Captured on a Bosch fundus camera; color fundus photograph: 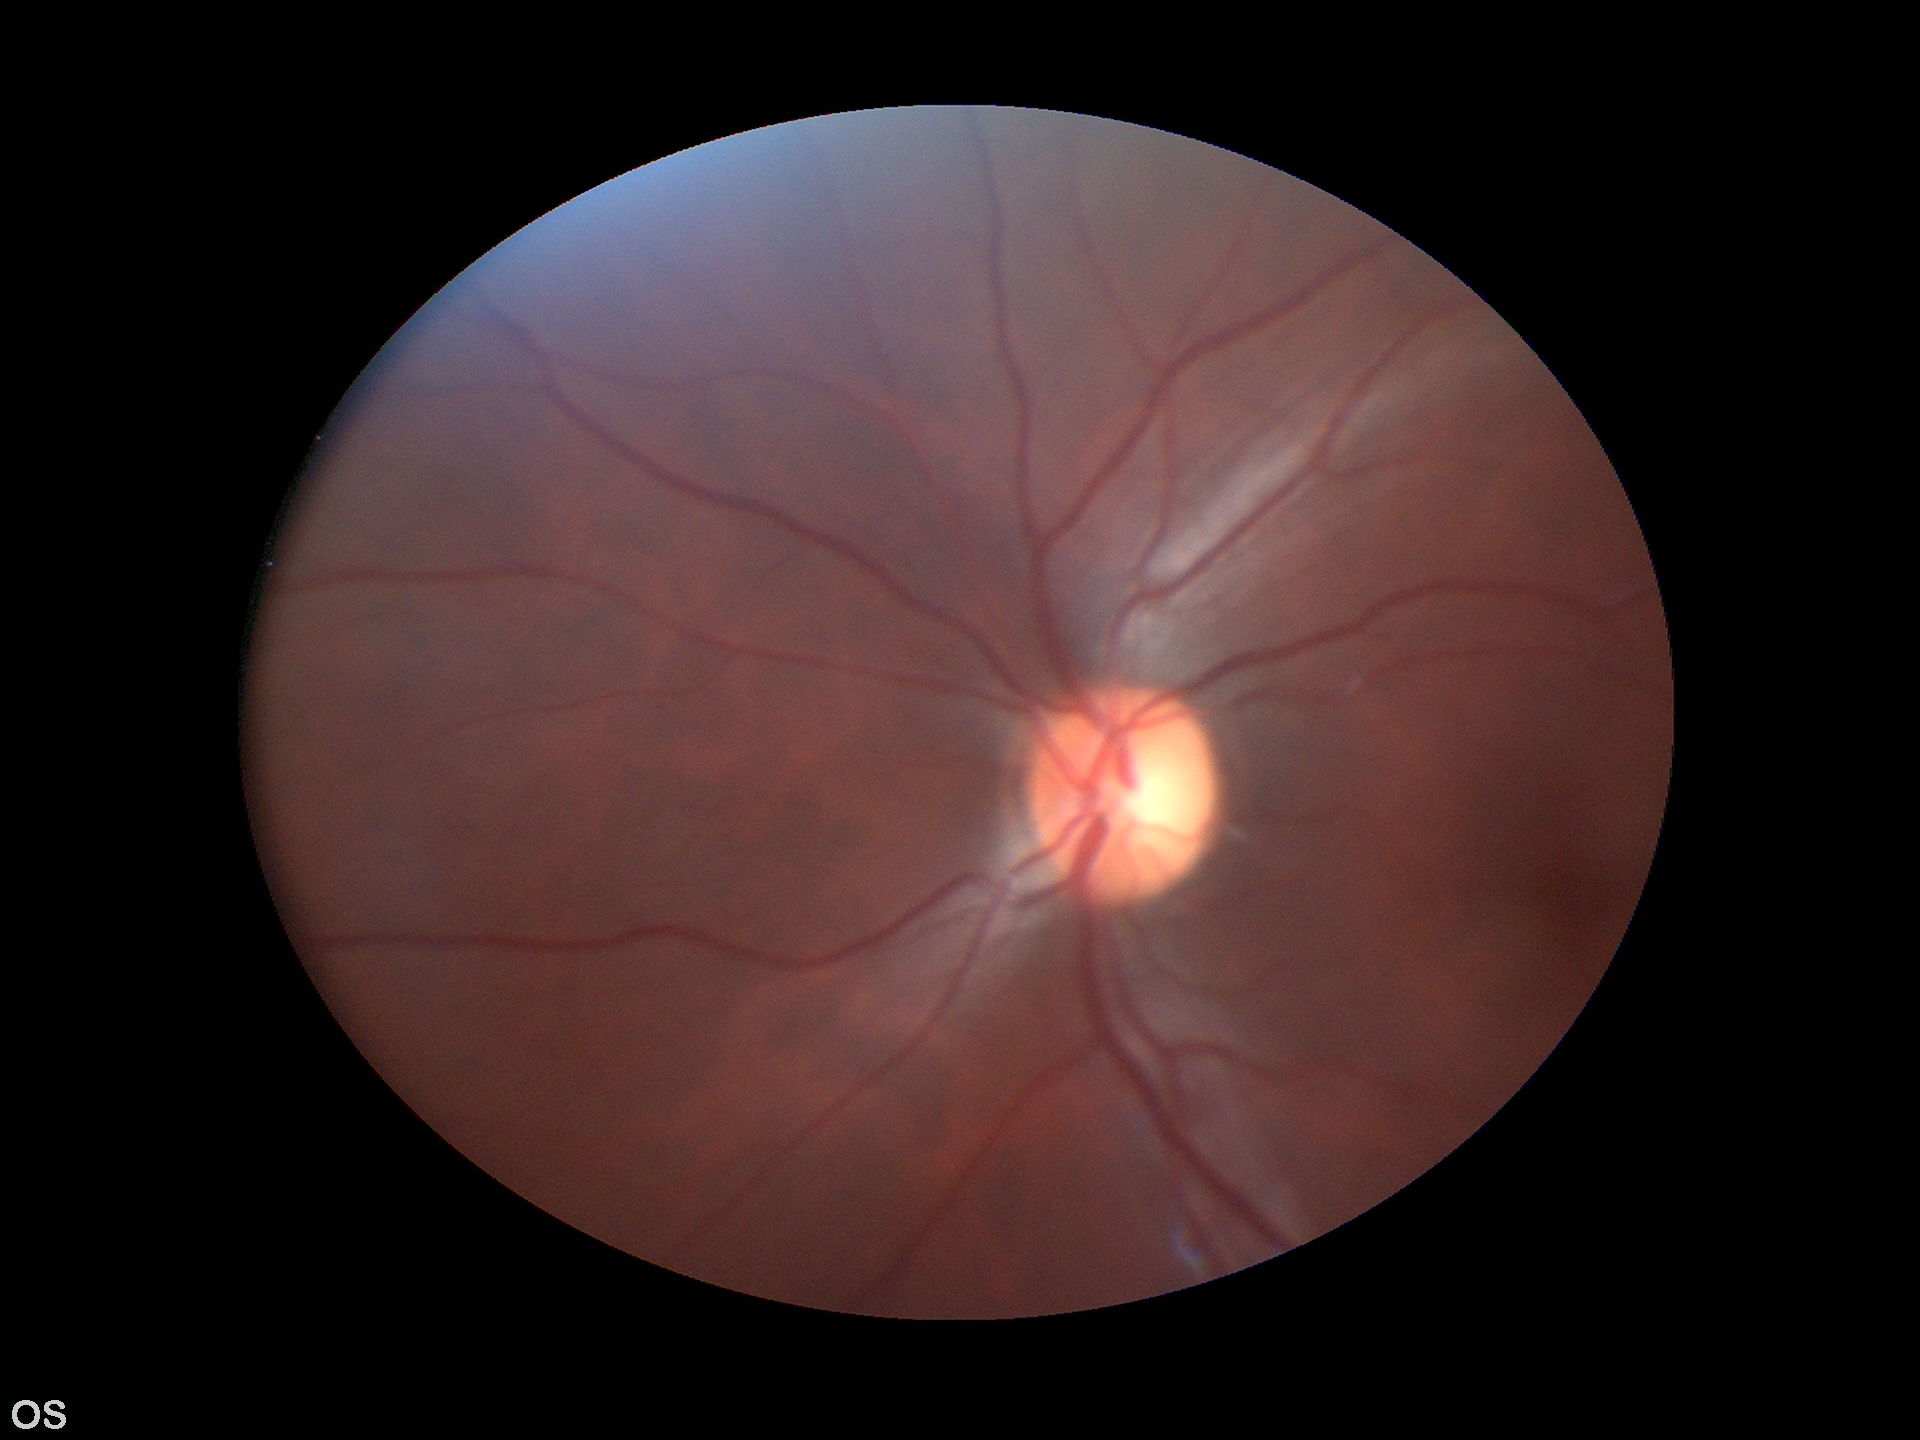

Glaucoma screening impression: negative.
Vertical C/D ratio (VCDR) of 0.50.